1240 x 1240 pixels; acquired on the Phoenix ICON; wide-field fundus image from infant ROP screening: 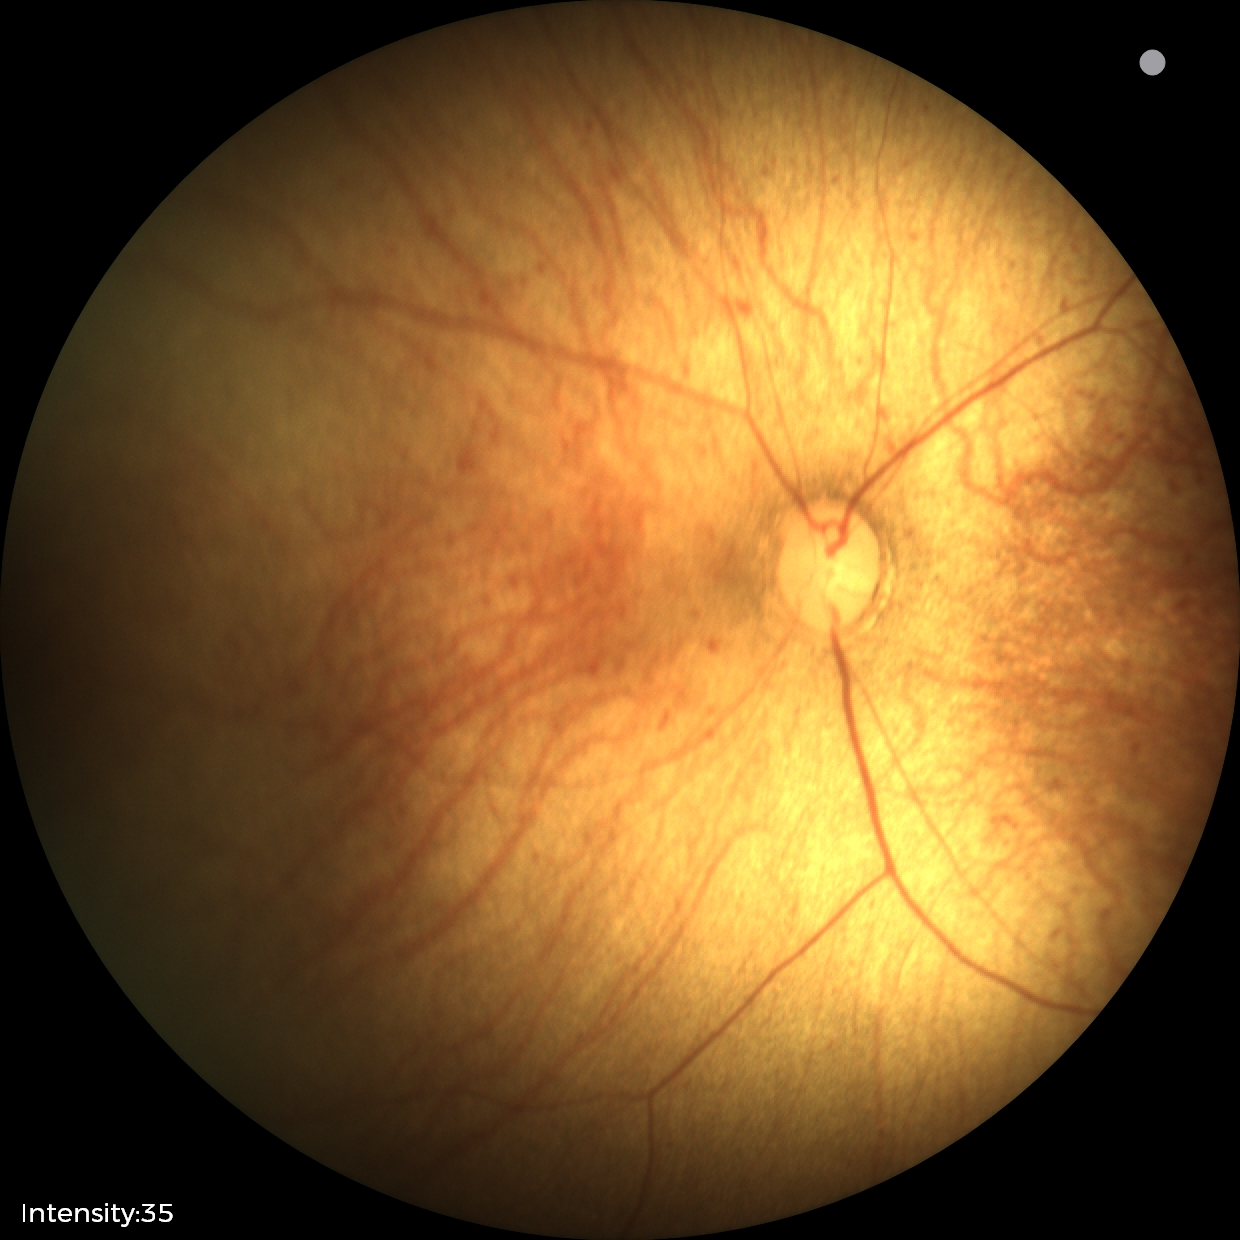 Physiological retinal appearance for postconceptual age.